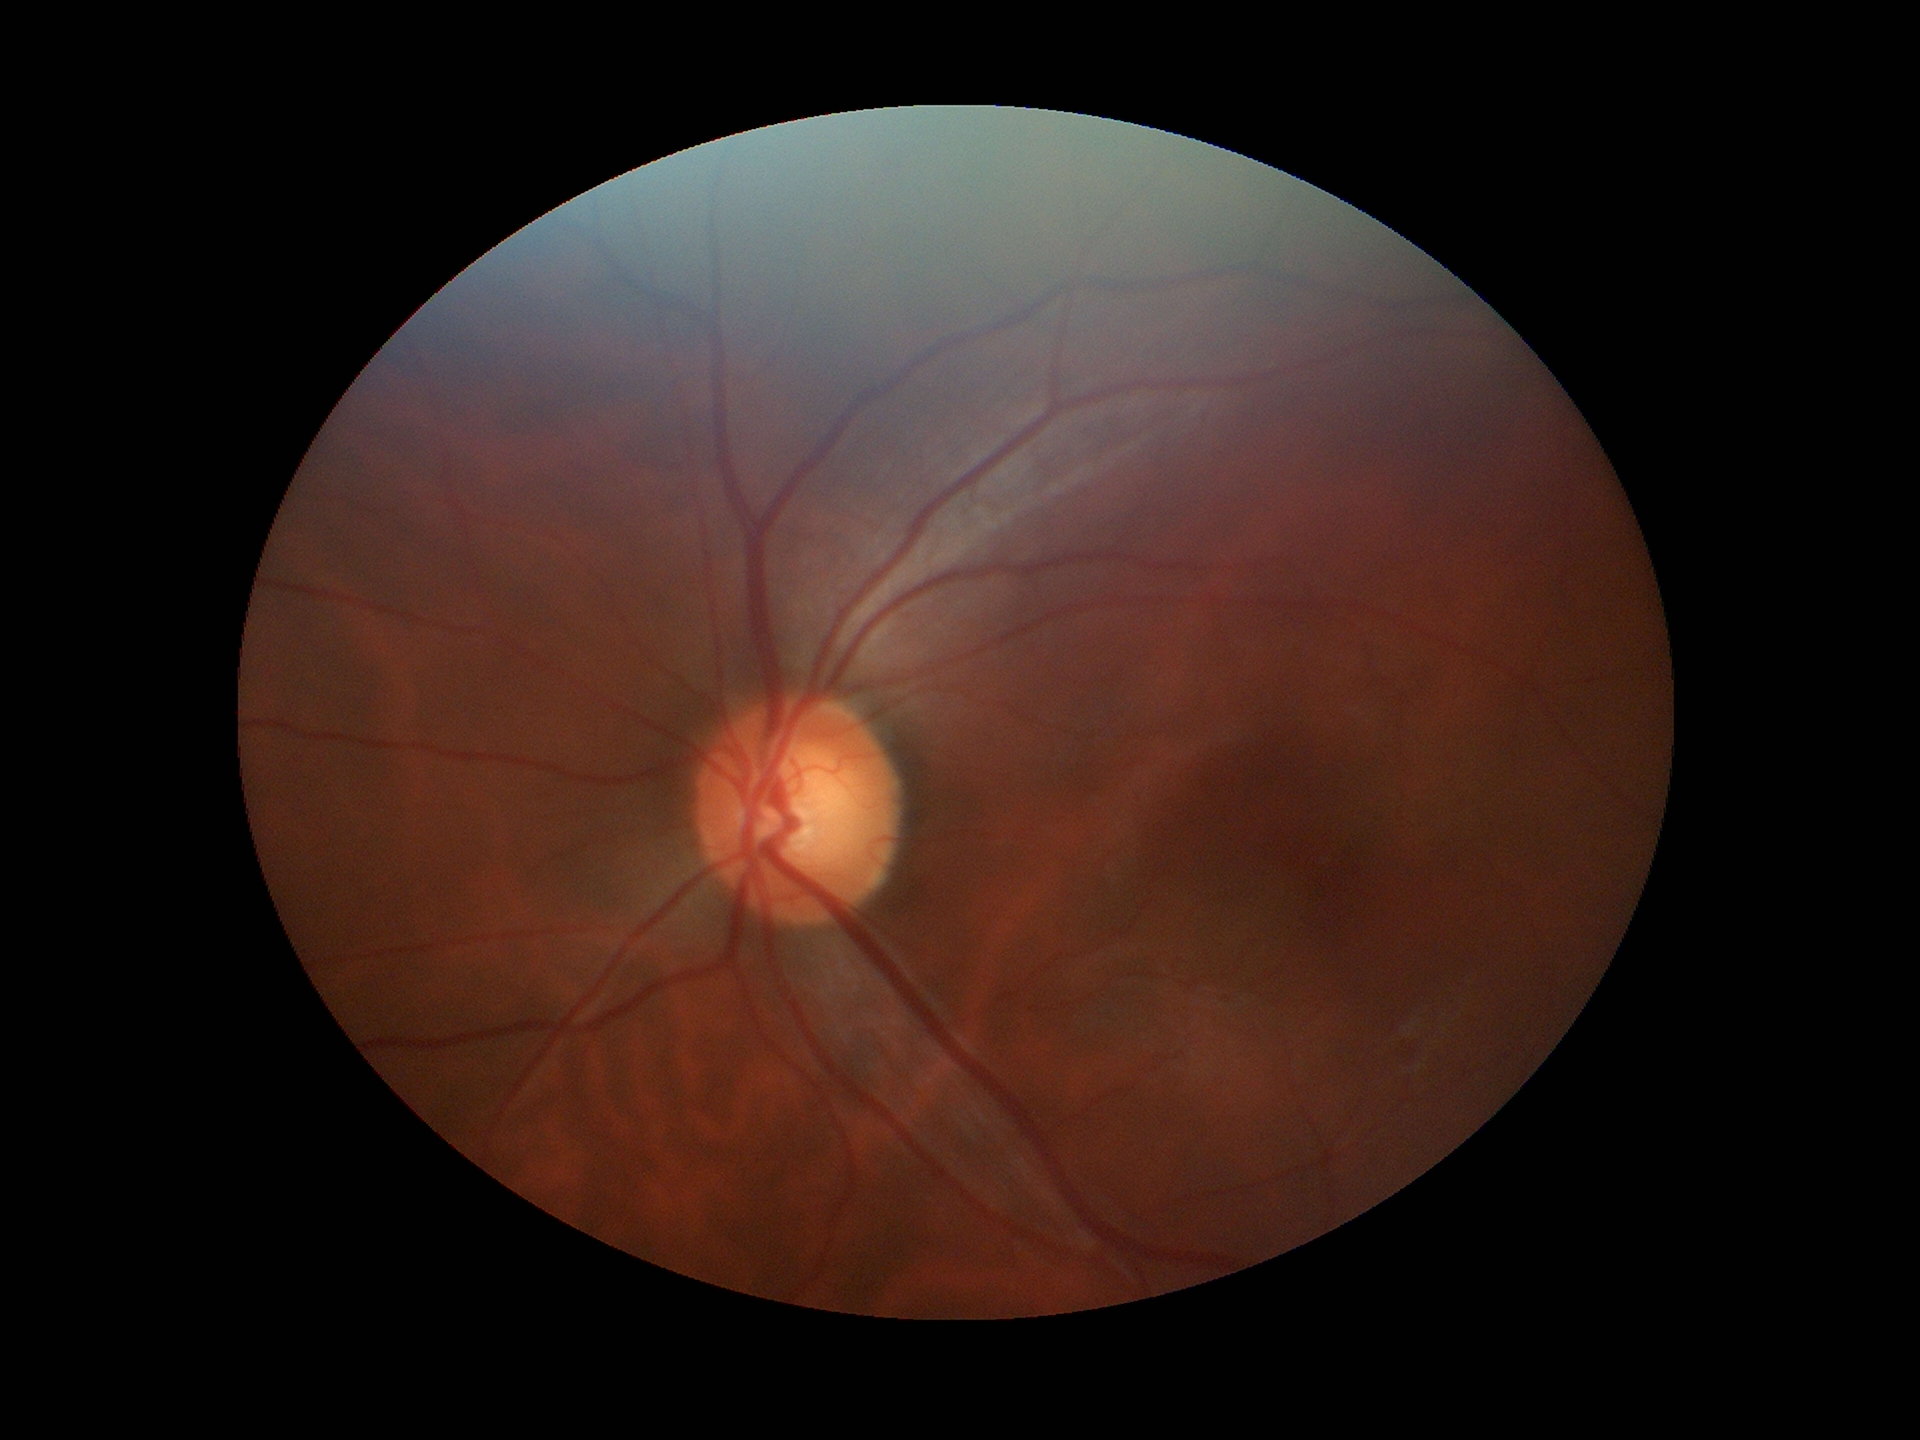 Findings:
– Glaucoma evaluation — not suspect
– VCDR — 0.58
– HCDR — 0.61